Fundus photo.
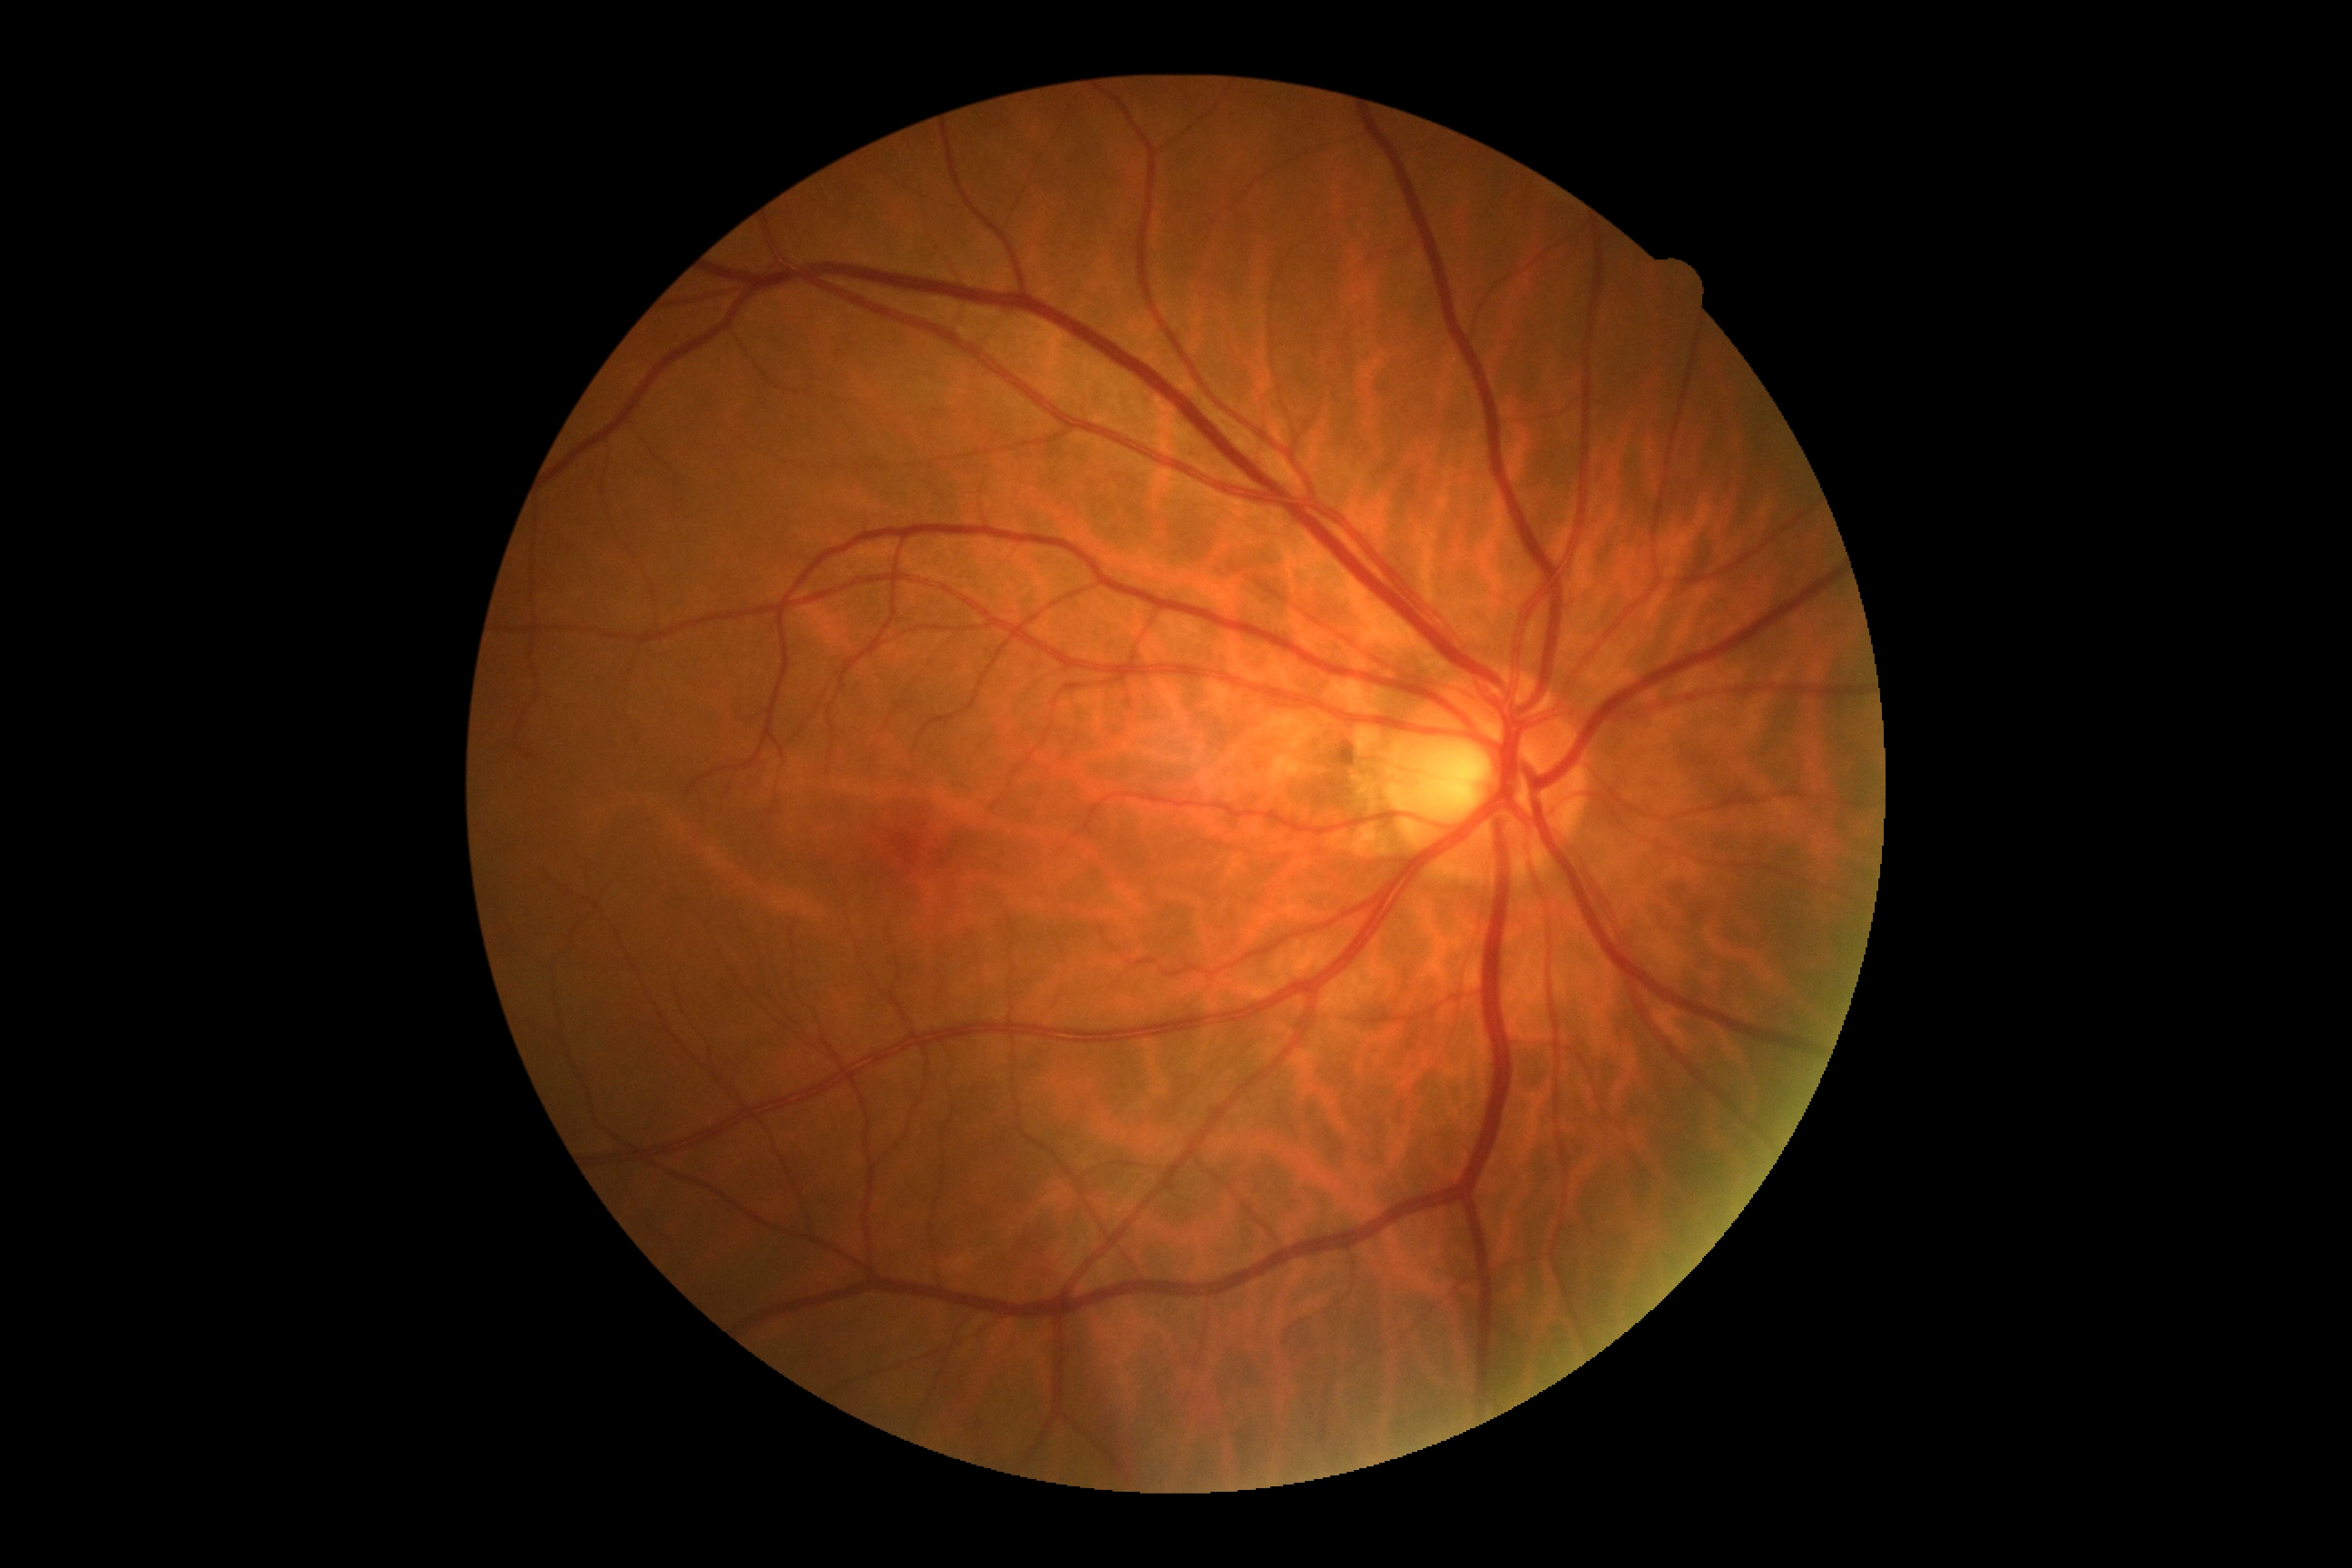 Annotations:
- DR impression — no apparent DR
- diabetic retinopathy — grade 0 (no apparent retinopathy) — no visible signs of diabetic retinopathy